Color fundus photograph; 45° field of view:
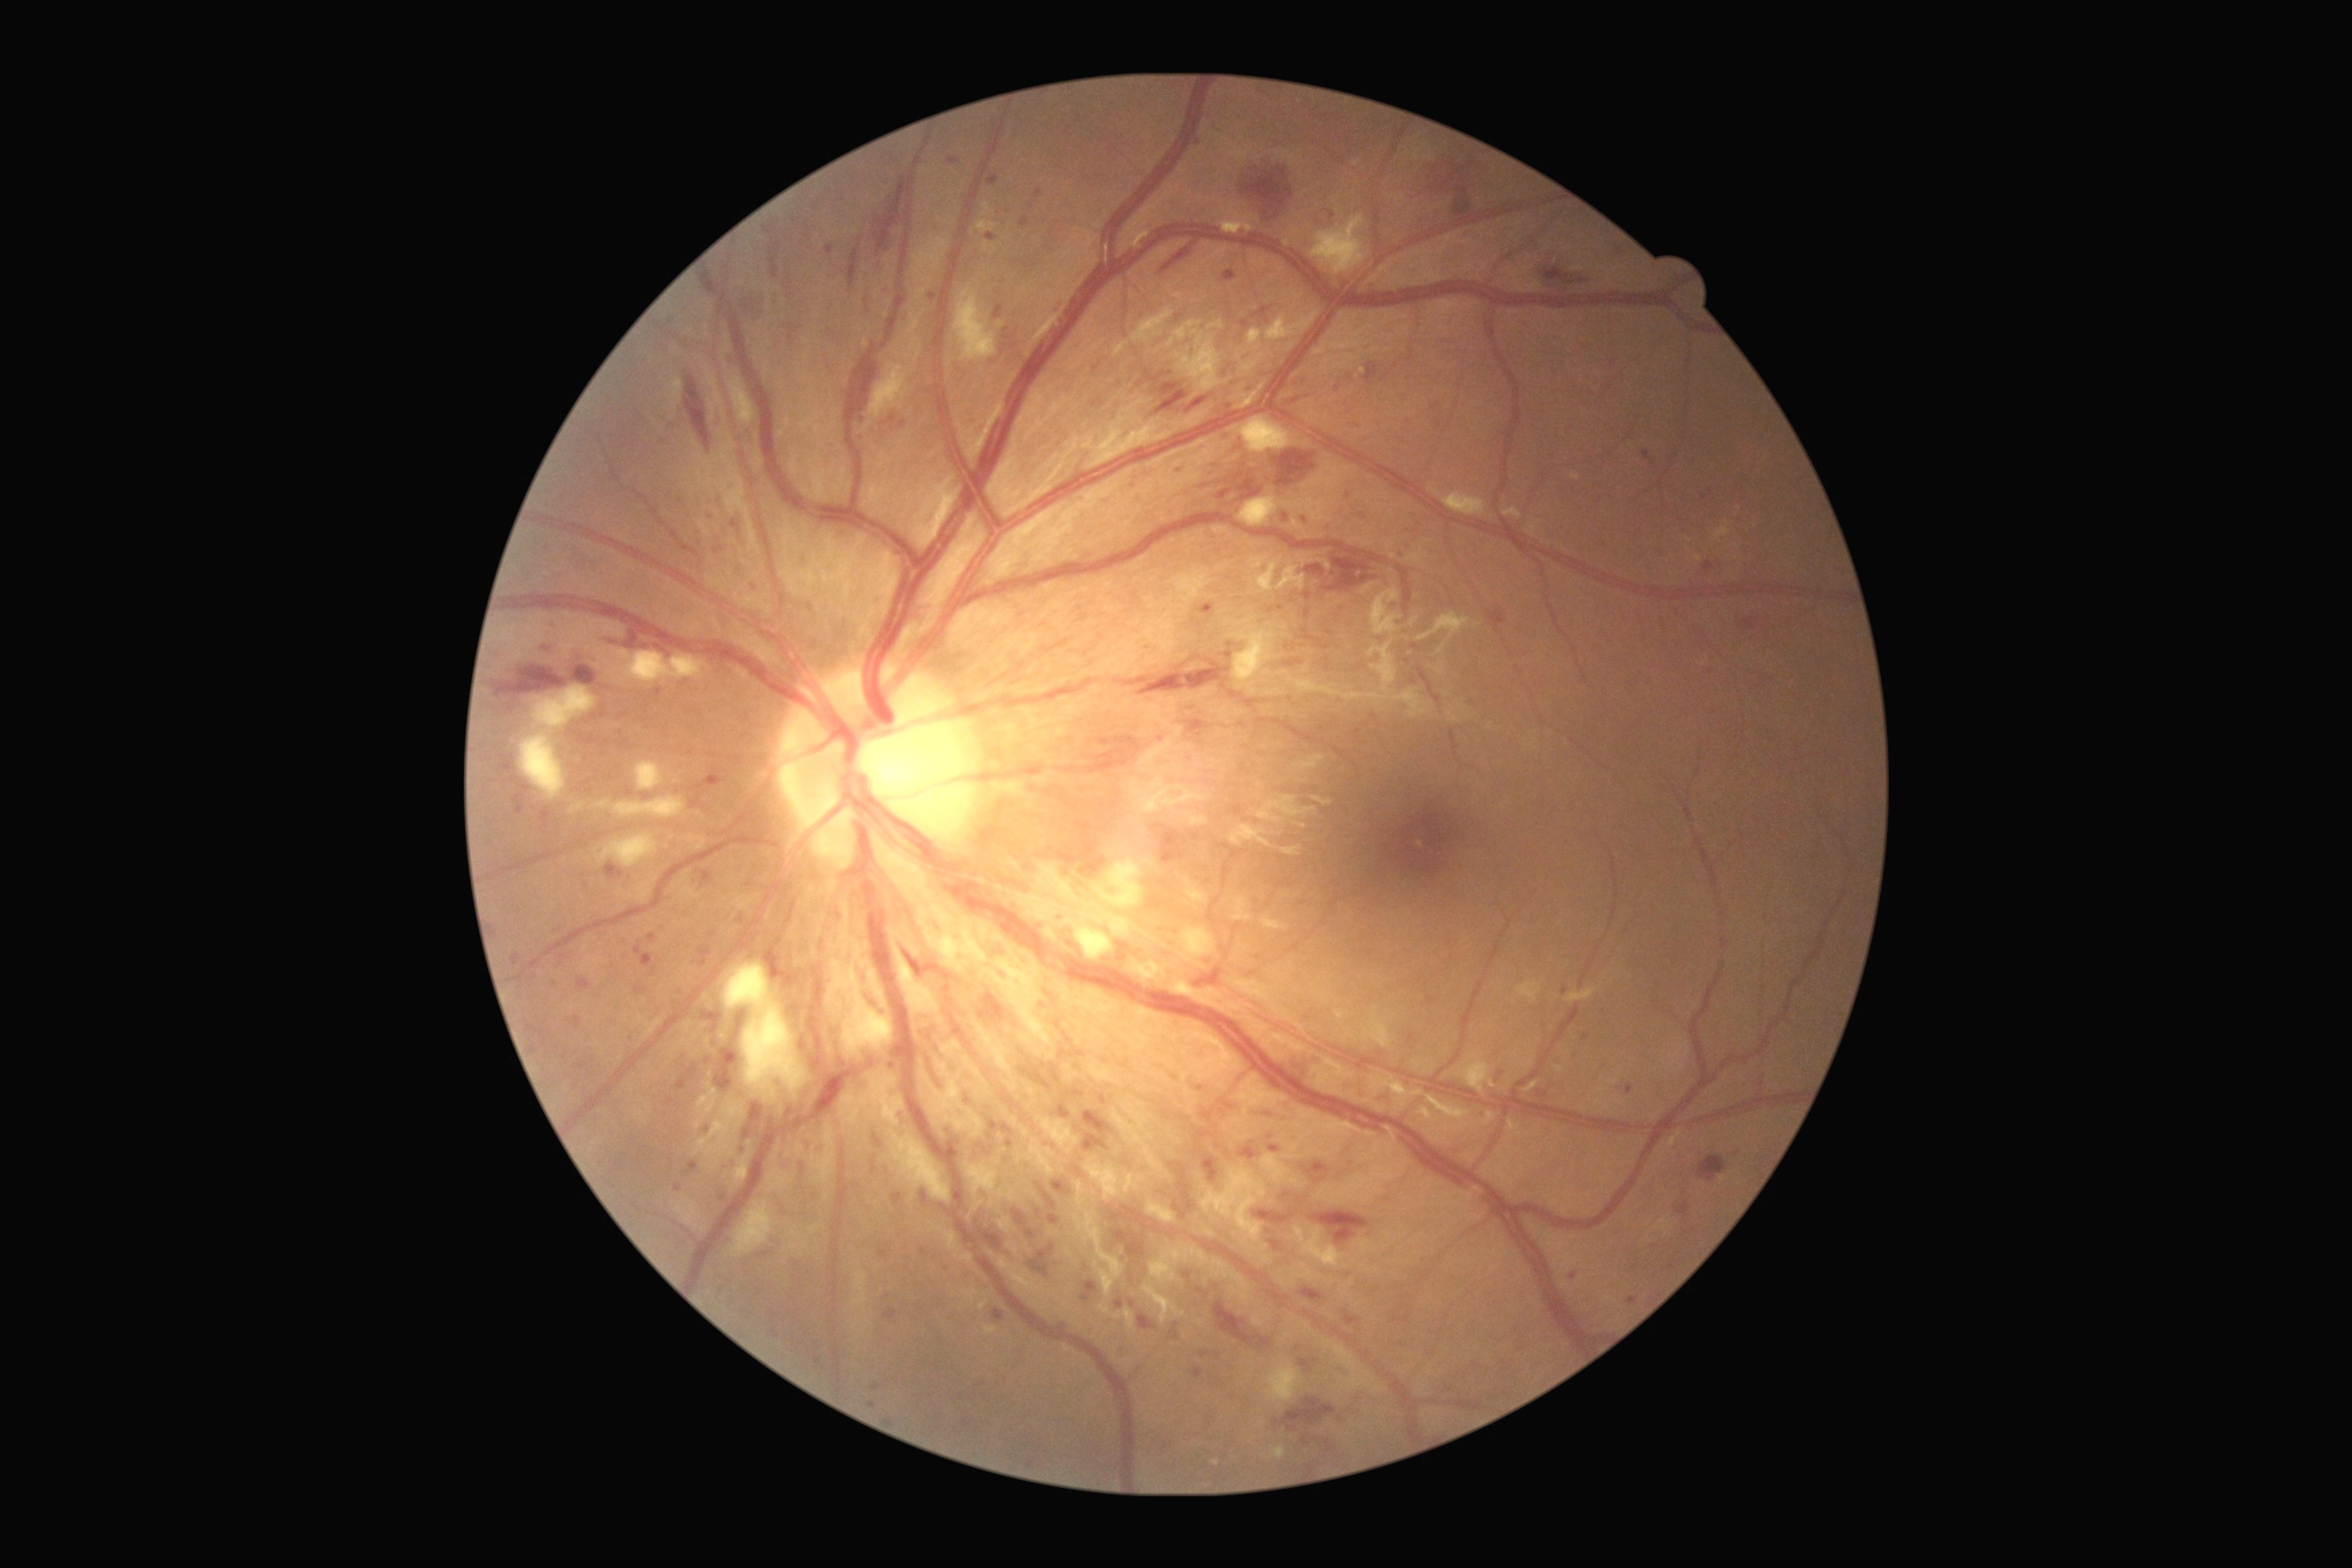 Diabetic retinopathy (DR) is grade 3 (severe NPDR)
Lesions identified (partial list):
• hemorrhages (HEs) (continued): 845, 240, 863, 286; 685, 377, 712, 451; 1186, 398, 1208, 413; 1242, 155, 1302, 220; 1157, 391, 1188, 415; 1186, 720, 1202, 723; 1215, 1302, 1271, 1349; 1378, 1092, 1393, 1102; 1424, 161, 1464, 195; 605, 632, 674, 658; 903, 950, 925, 979; 1346, 1079, 1367, 1097; 1014, 1210, 1026, 1226; 714, 1044, 738, 1093; 1262, 1108, 1271, 1119
• Small HEs near {"x": 628, "y": 630}
• microaneurysms (MAs) (continued): 1190, 1367, 1204, 1378; 732, 520, 741, 534; 816, 1358, 821, 1366; 874, 1135, 883, 1148; 1255, 1210, 1295, 1224; 872, 1384, 881, 1391; 574, 1015, 582, 1028; 1300, 1288, 1324, 1302; 948, 159, 959, 166; 591, 709, 607, 721; 839, 531, 847, 538
• Small MAs near {"x": 707, "y": 1130}; {"x": 874, "y": 1169}; {"x": 867, "y": 301}; {"x": 1574, "y": 1277}; {"x": 1628, "y": 1089}; {"x": 816, "y": 208}; {"x": 1315, "y": 1362}; {"x": 1162, "y": 739}
• soft exudates (SEs) (continued): 1230, 418, 1295, 455; 954, 286, 1004, 362; 870, 364, 910, 418; 1235, 618, 1279, 696; 1208, 320, 1224, 331; 1133, 963, 1168, 981; 571, 805, 583, 814; 1090, 912, 1133, 937; 1266, 1358, 1302, 1402; 618, 651, 701, 685; 729, 377, 756, 426; 828, 957, 894, 1055; 1233, 896, 1251, 923; 979, 921, 990, 943; 1142, 861, 1153, 865; 520, 732, 565, 801
• Small SEs near {"x": 1088, "y": 906}; {"x": 1084, "y": 916}